Cropped to the optic nerve head:
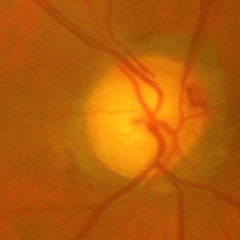
Glaucoma stage = severe glaucomatous damage.